Phoenix ICON wide-field infant fundus image — 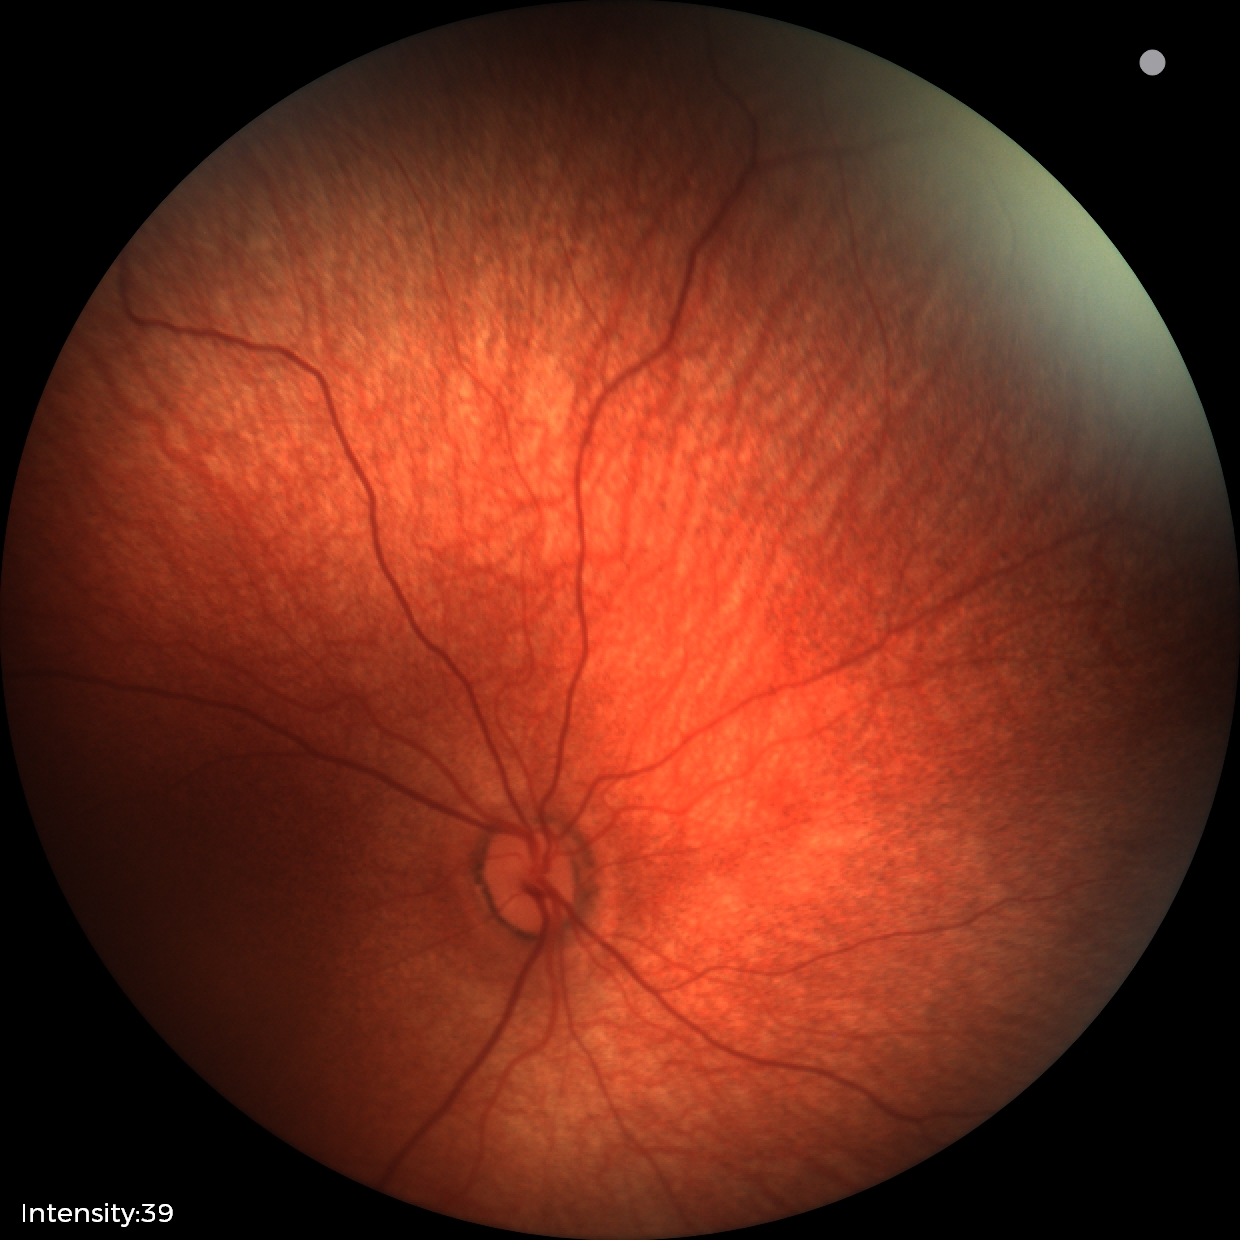 Screening diagnosis = normal retinal appearance.